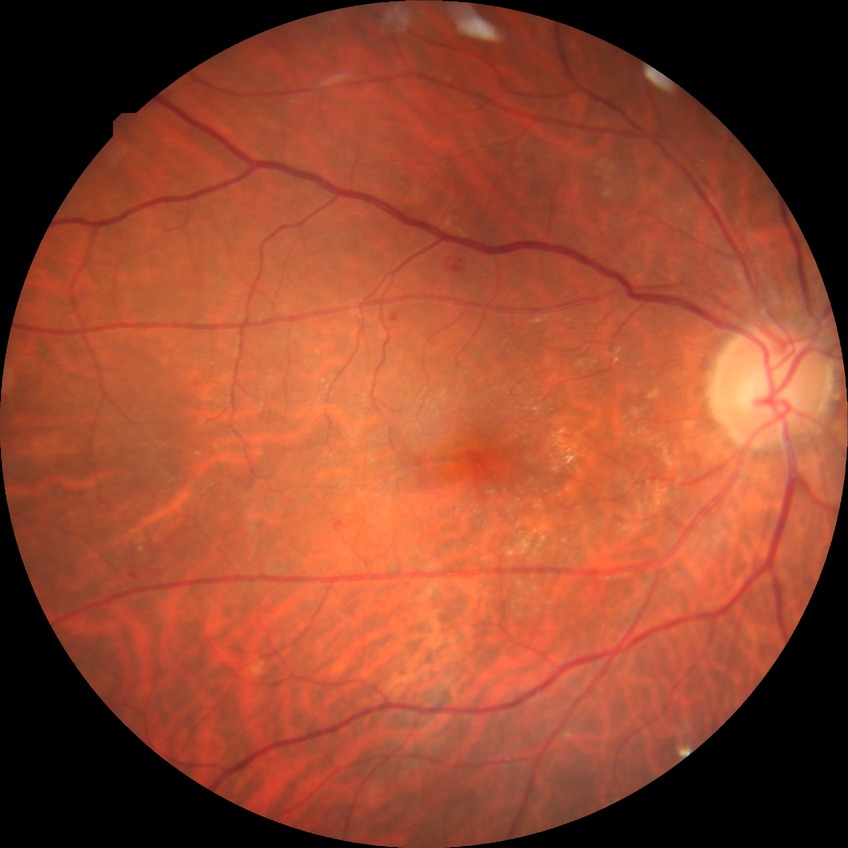 Davis DR grade: SDR.